1932x1916px:
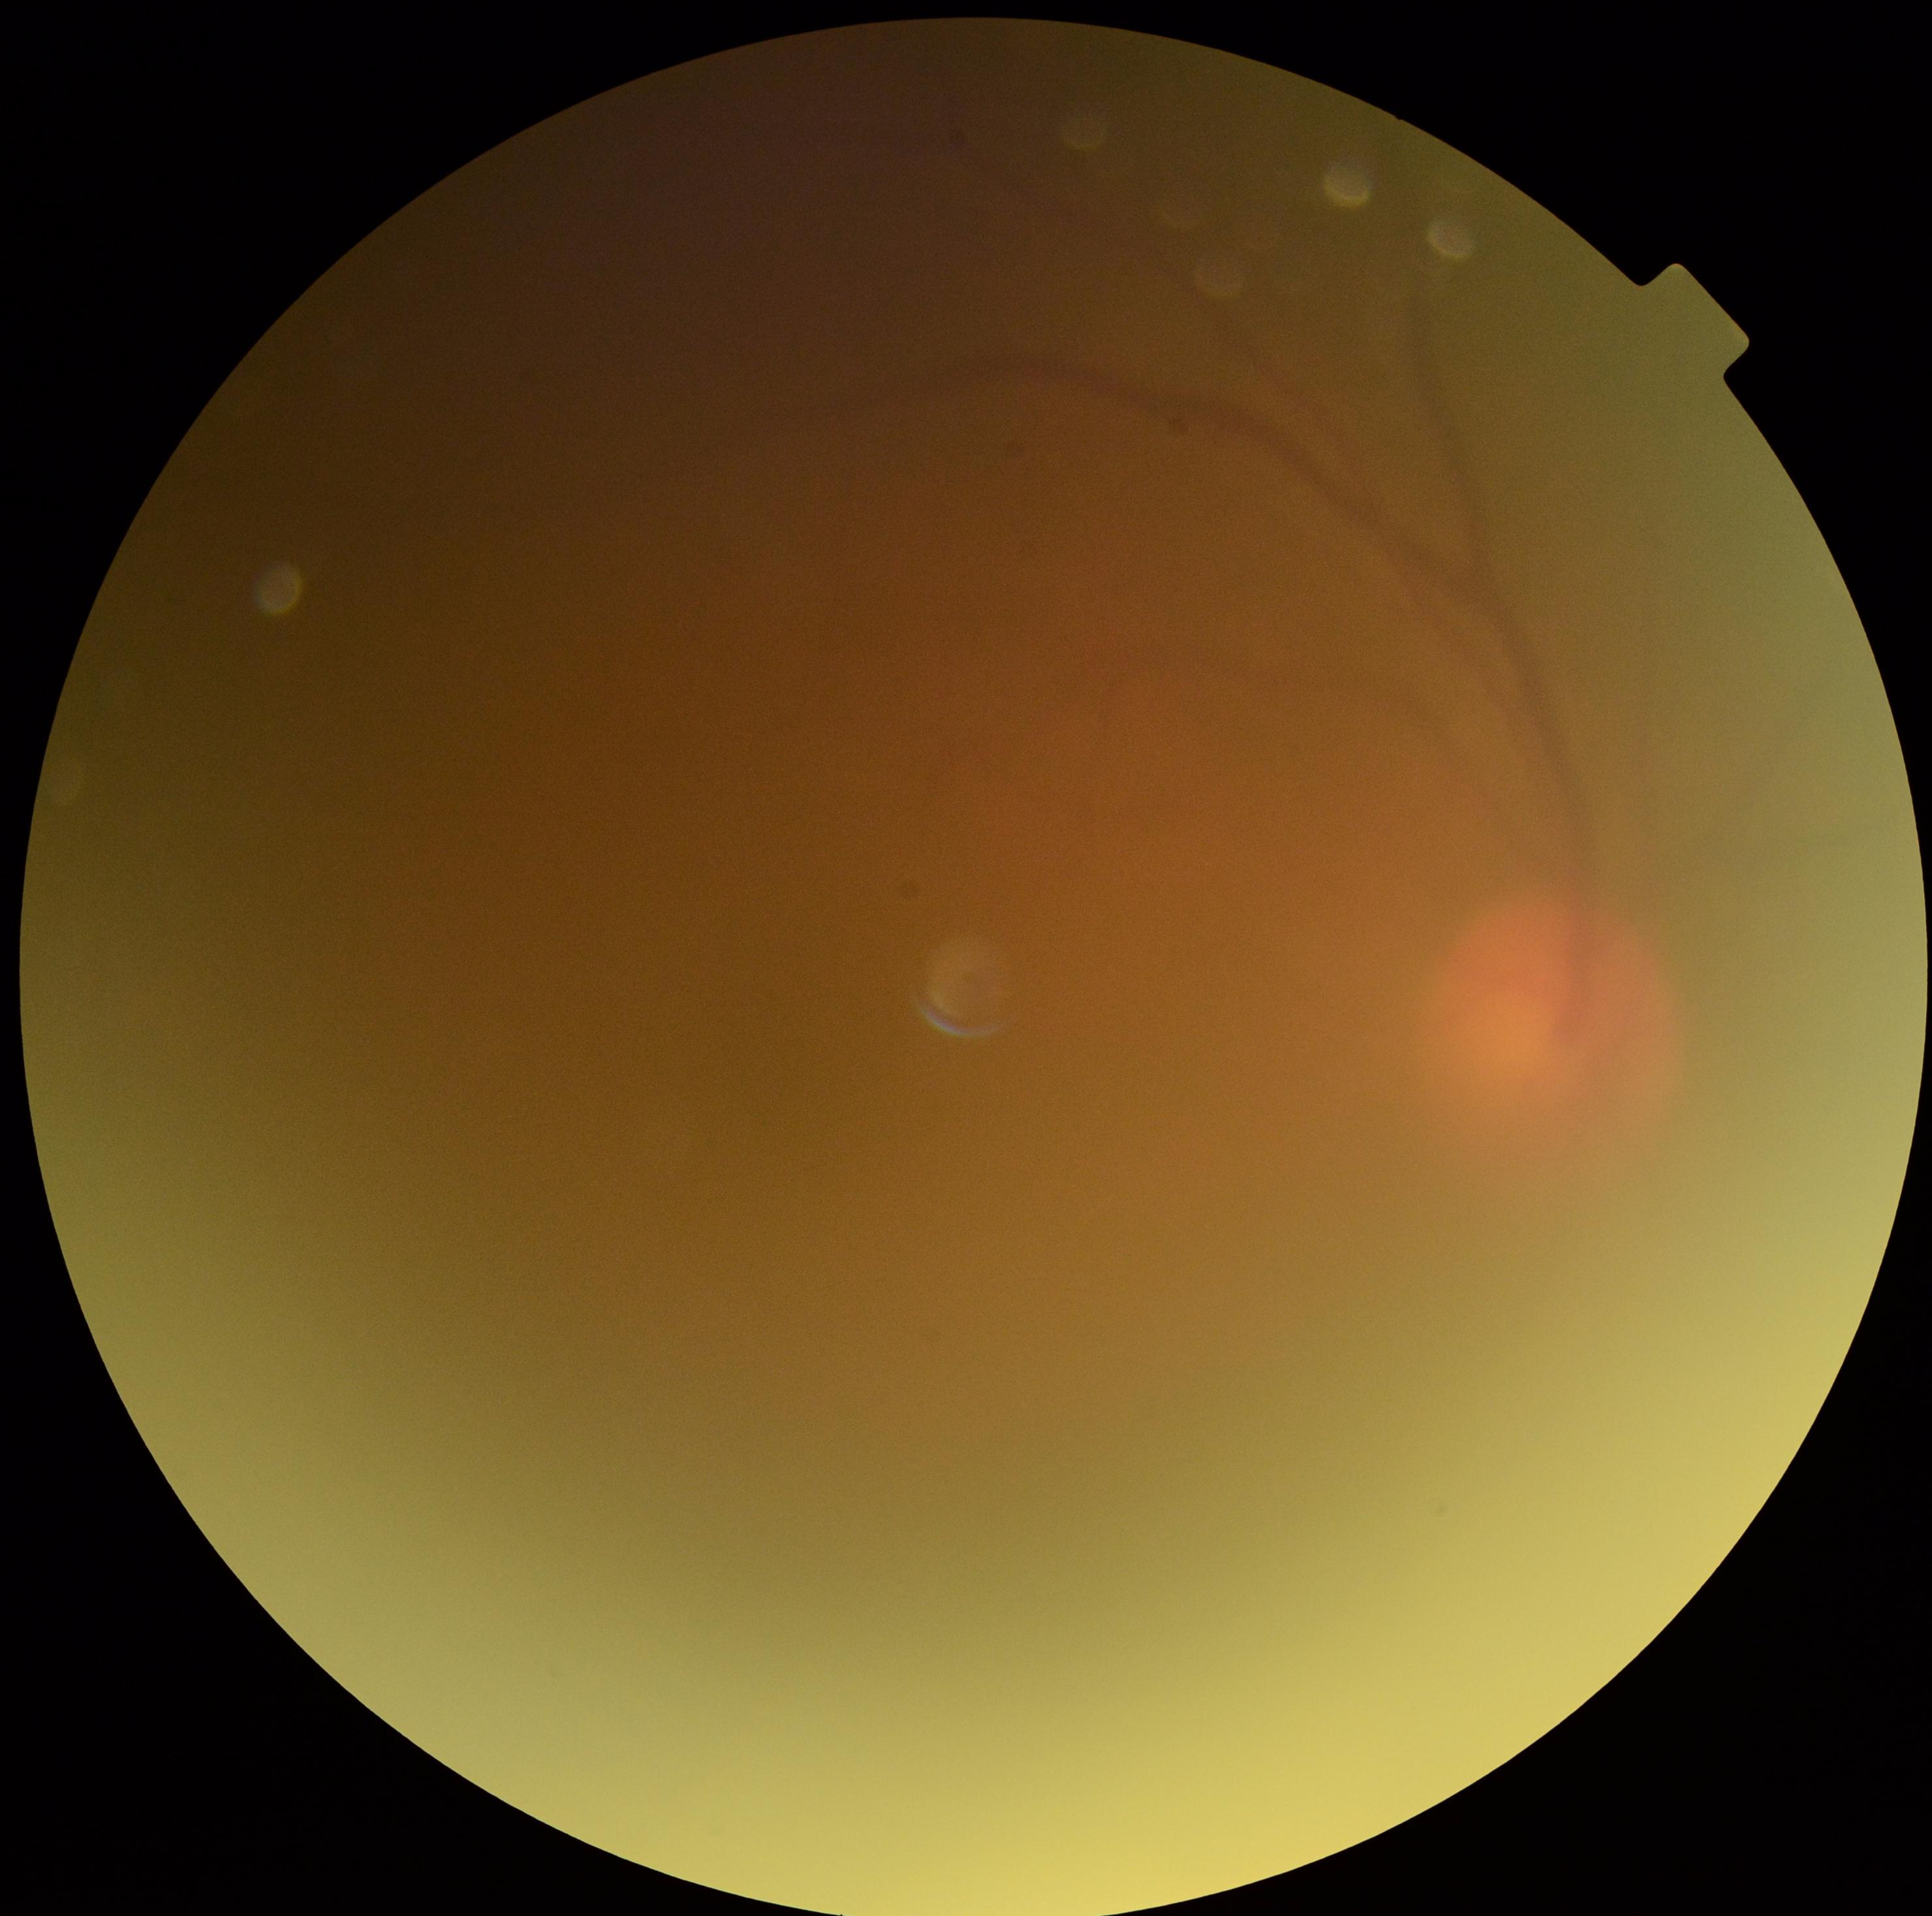

image quality: below grading threshold, DR: ungradable due to poor image quality.